1380x1382 — 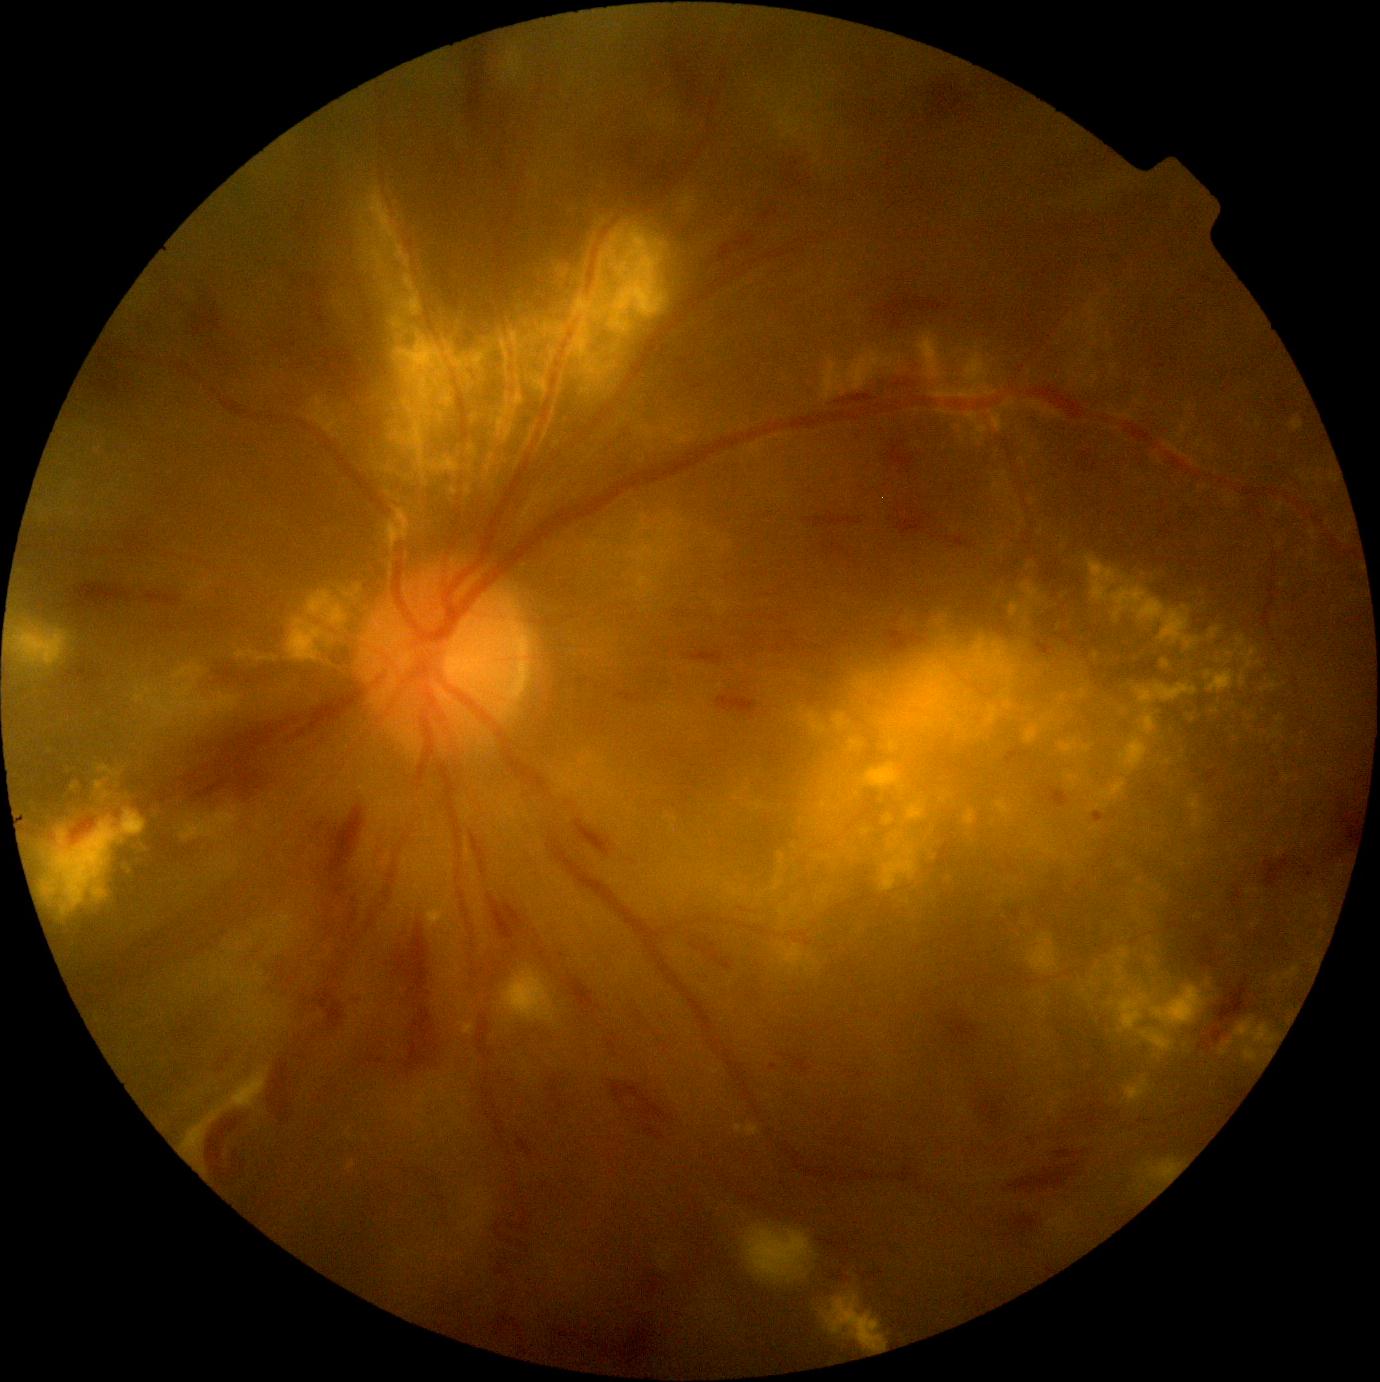
DR grade is 3 (severe NPDR) — more than 20 intraretinal hemorrhages in each of 4 quadrants, definite venous beading in 2 or more quadrants, or prominent intraretinal microvascular abnormalities in 1 or more quadrants, with no signs of proliferative retinopathy.